Color fundus image.
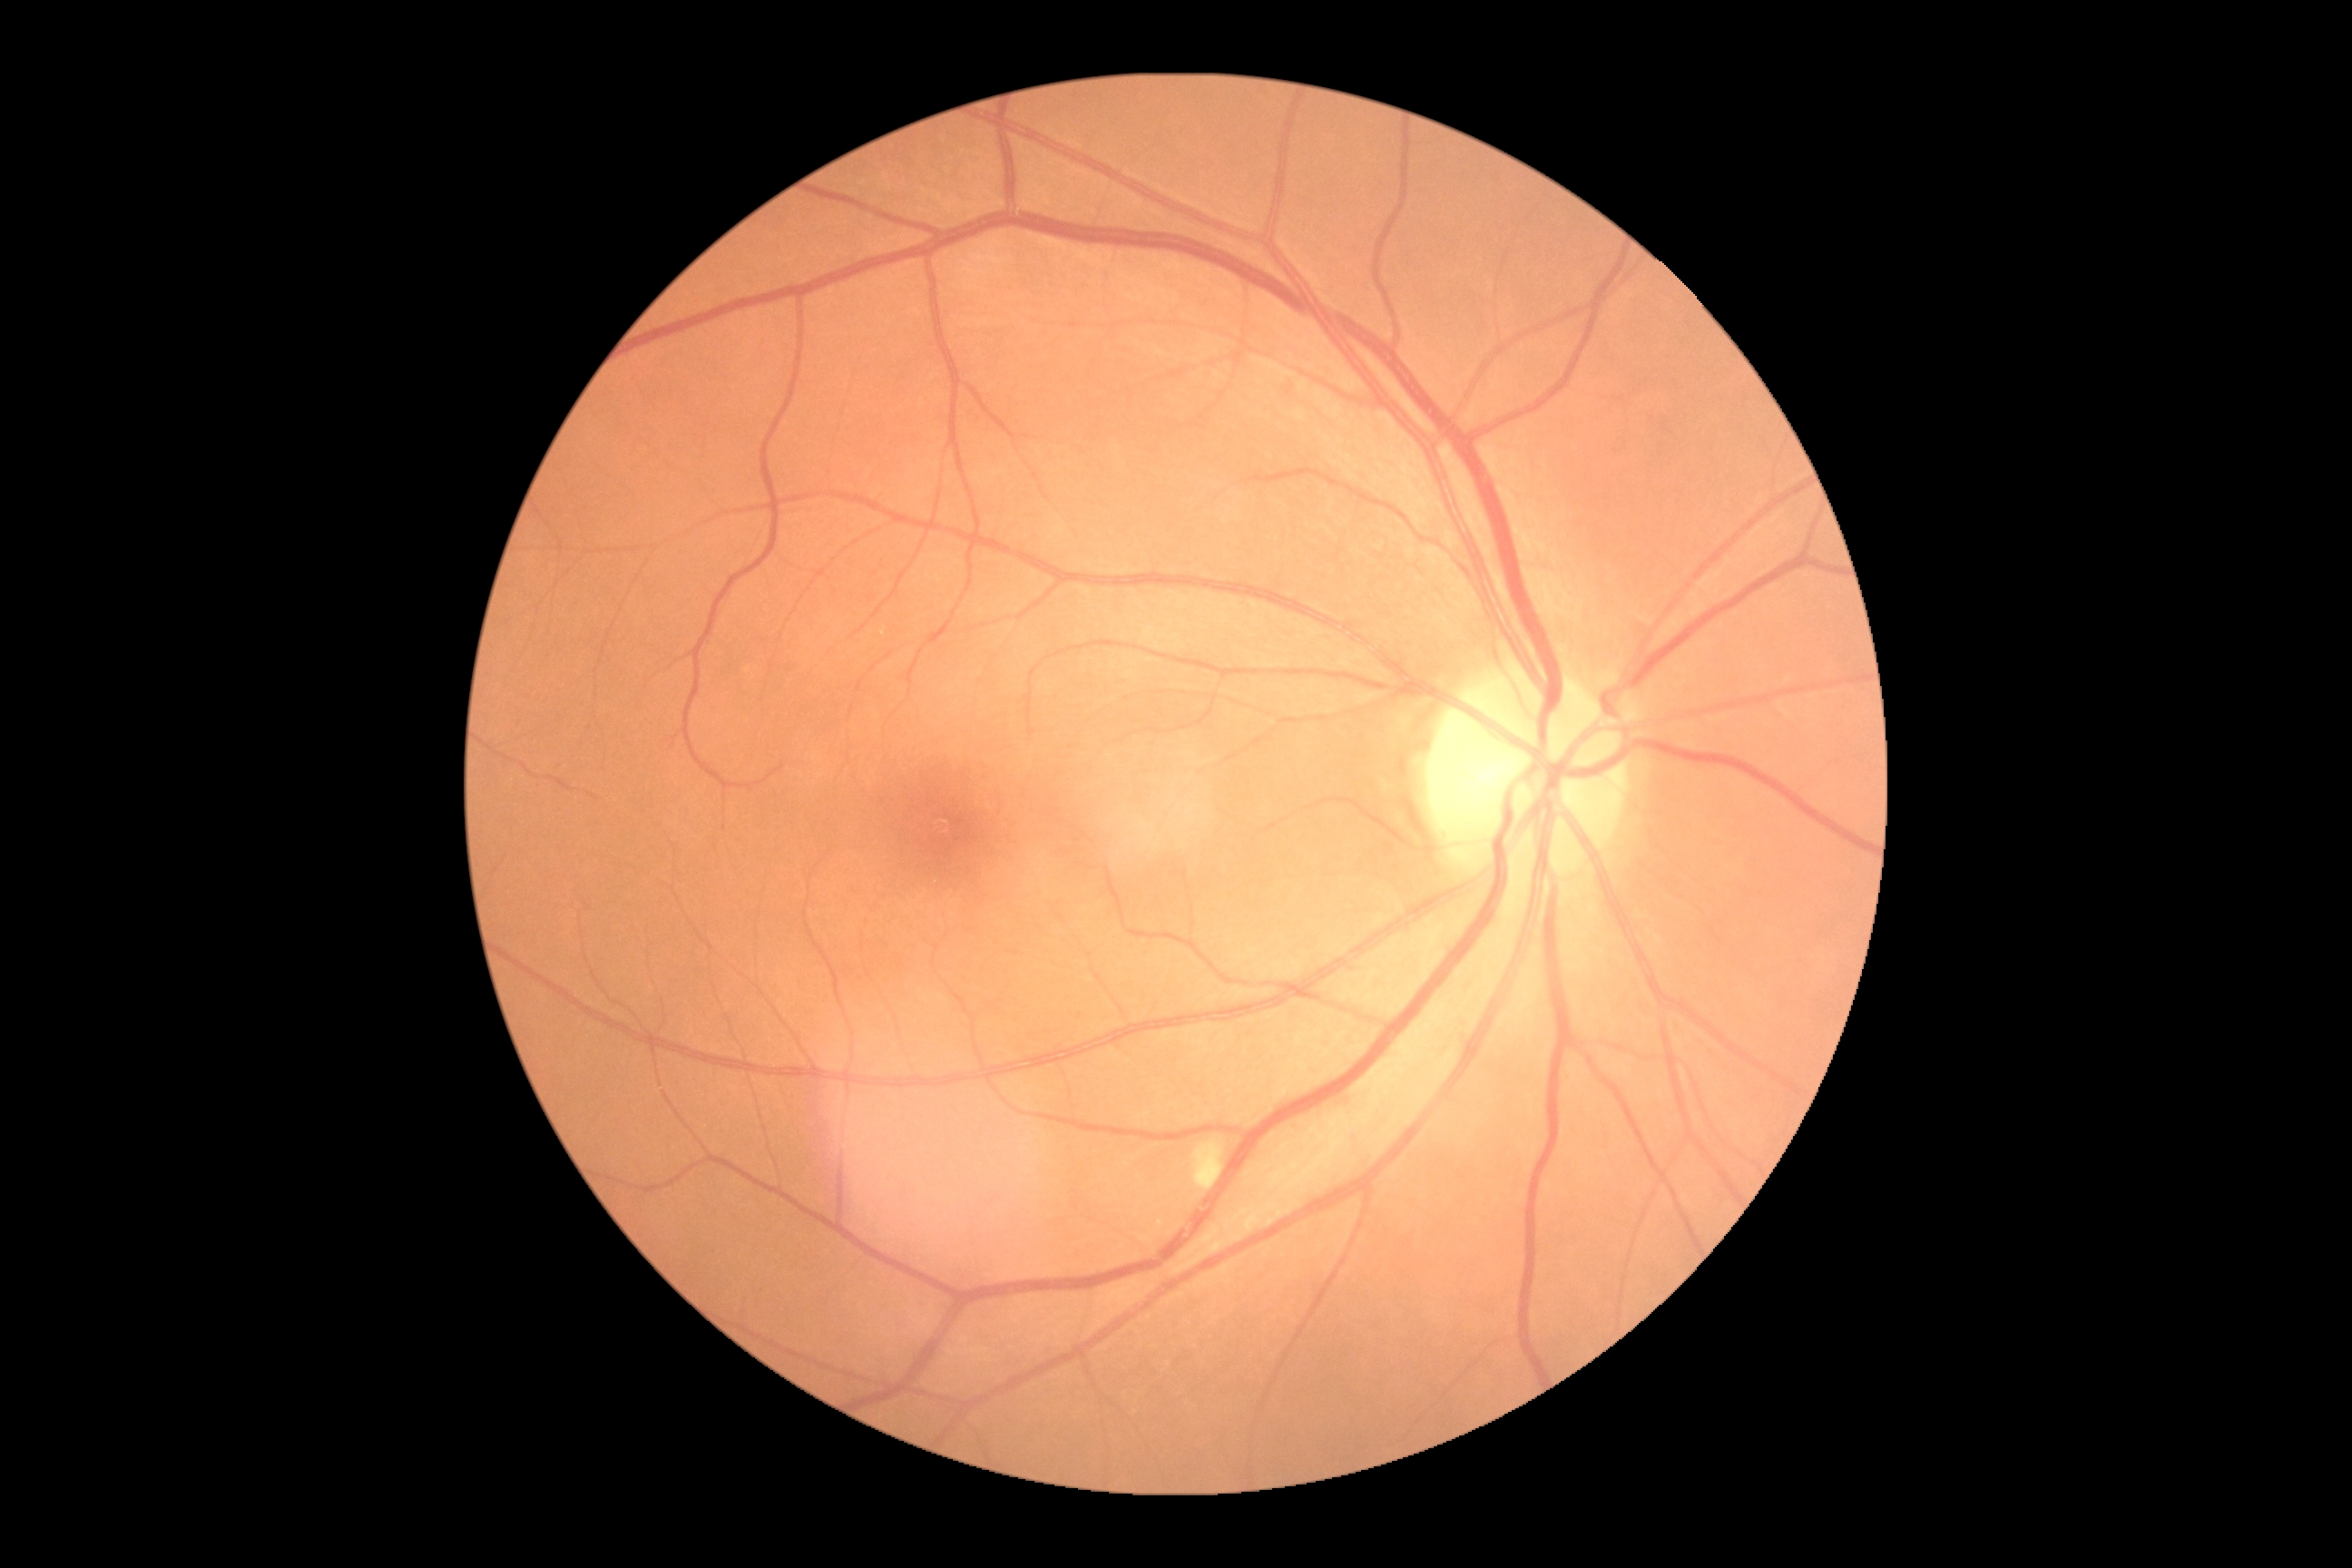 – DR — 2/4